Optic disc photograph · 532x532px:
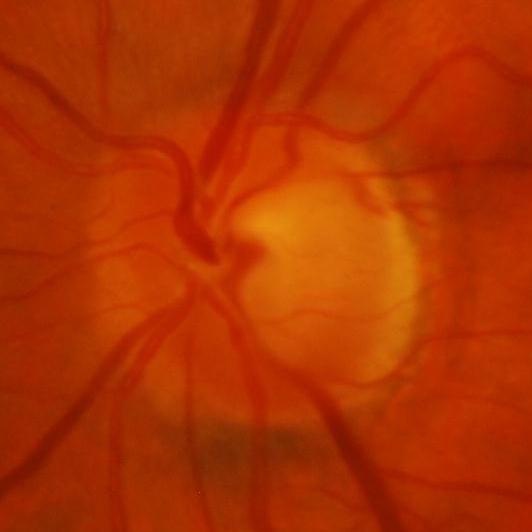 Diagnosis = glaucomatous optic neuropathy.